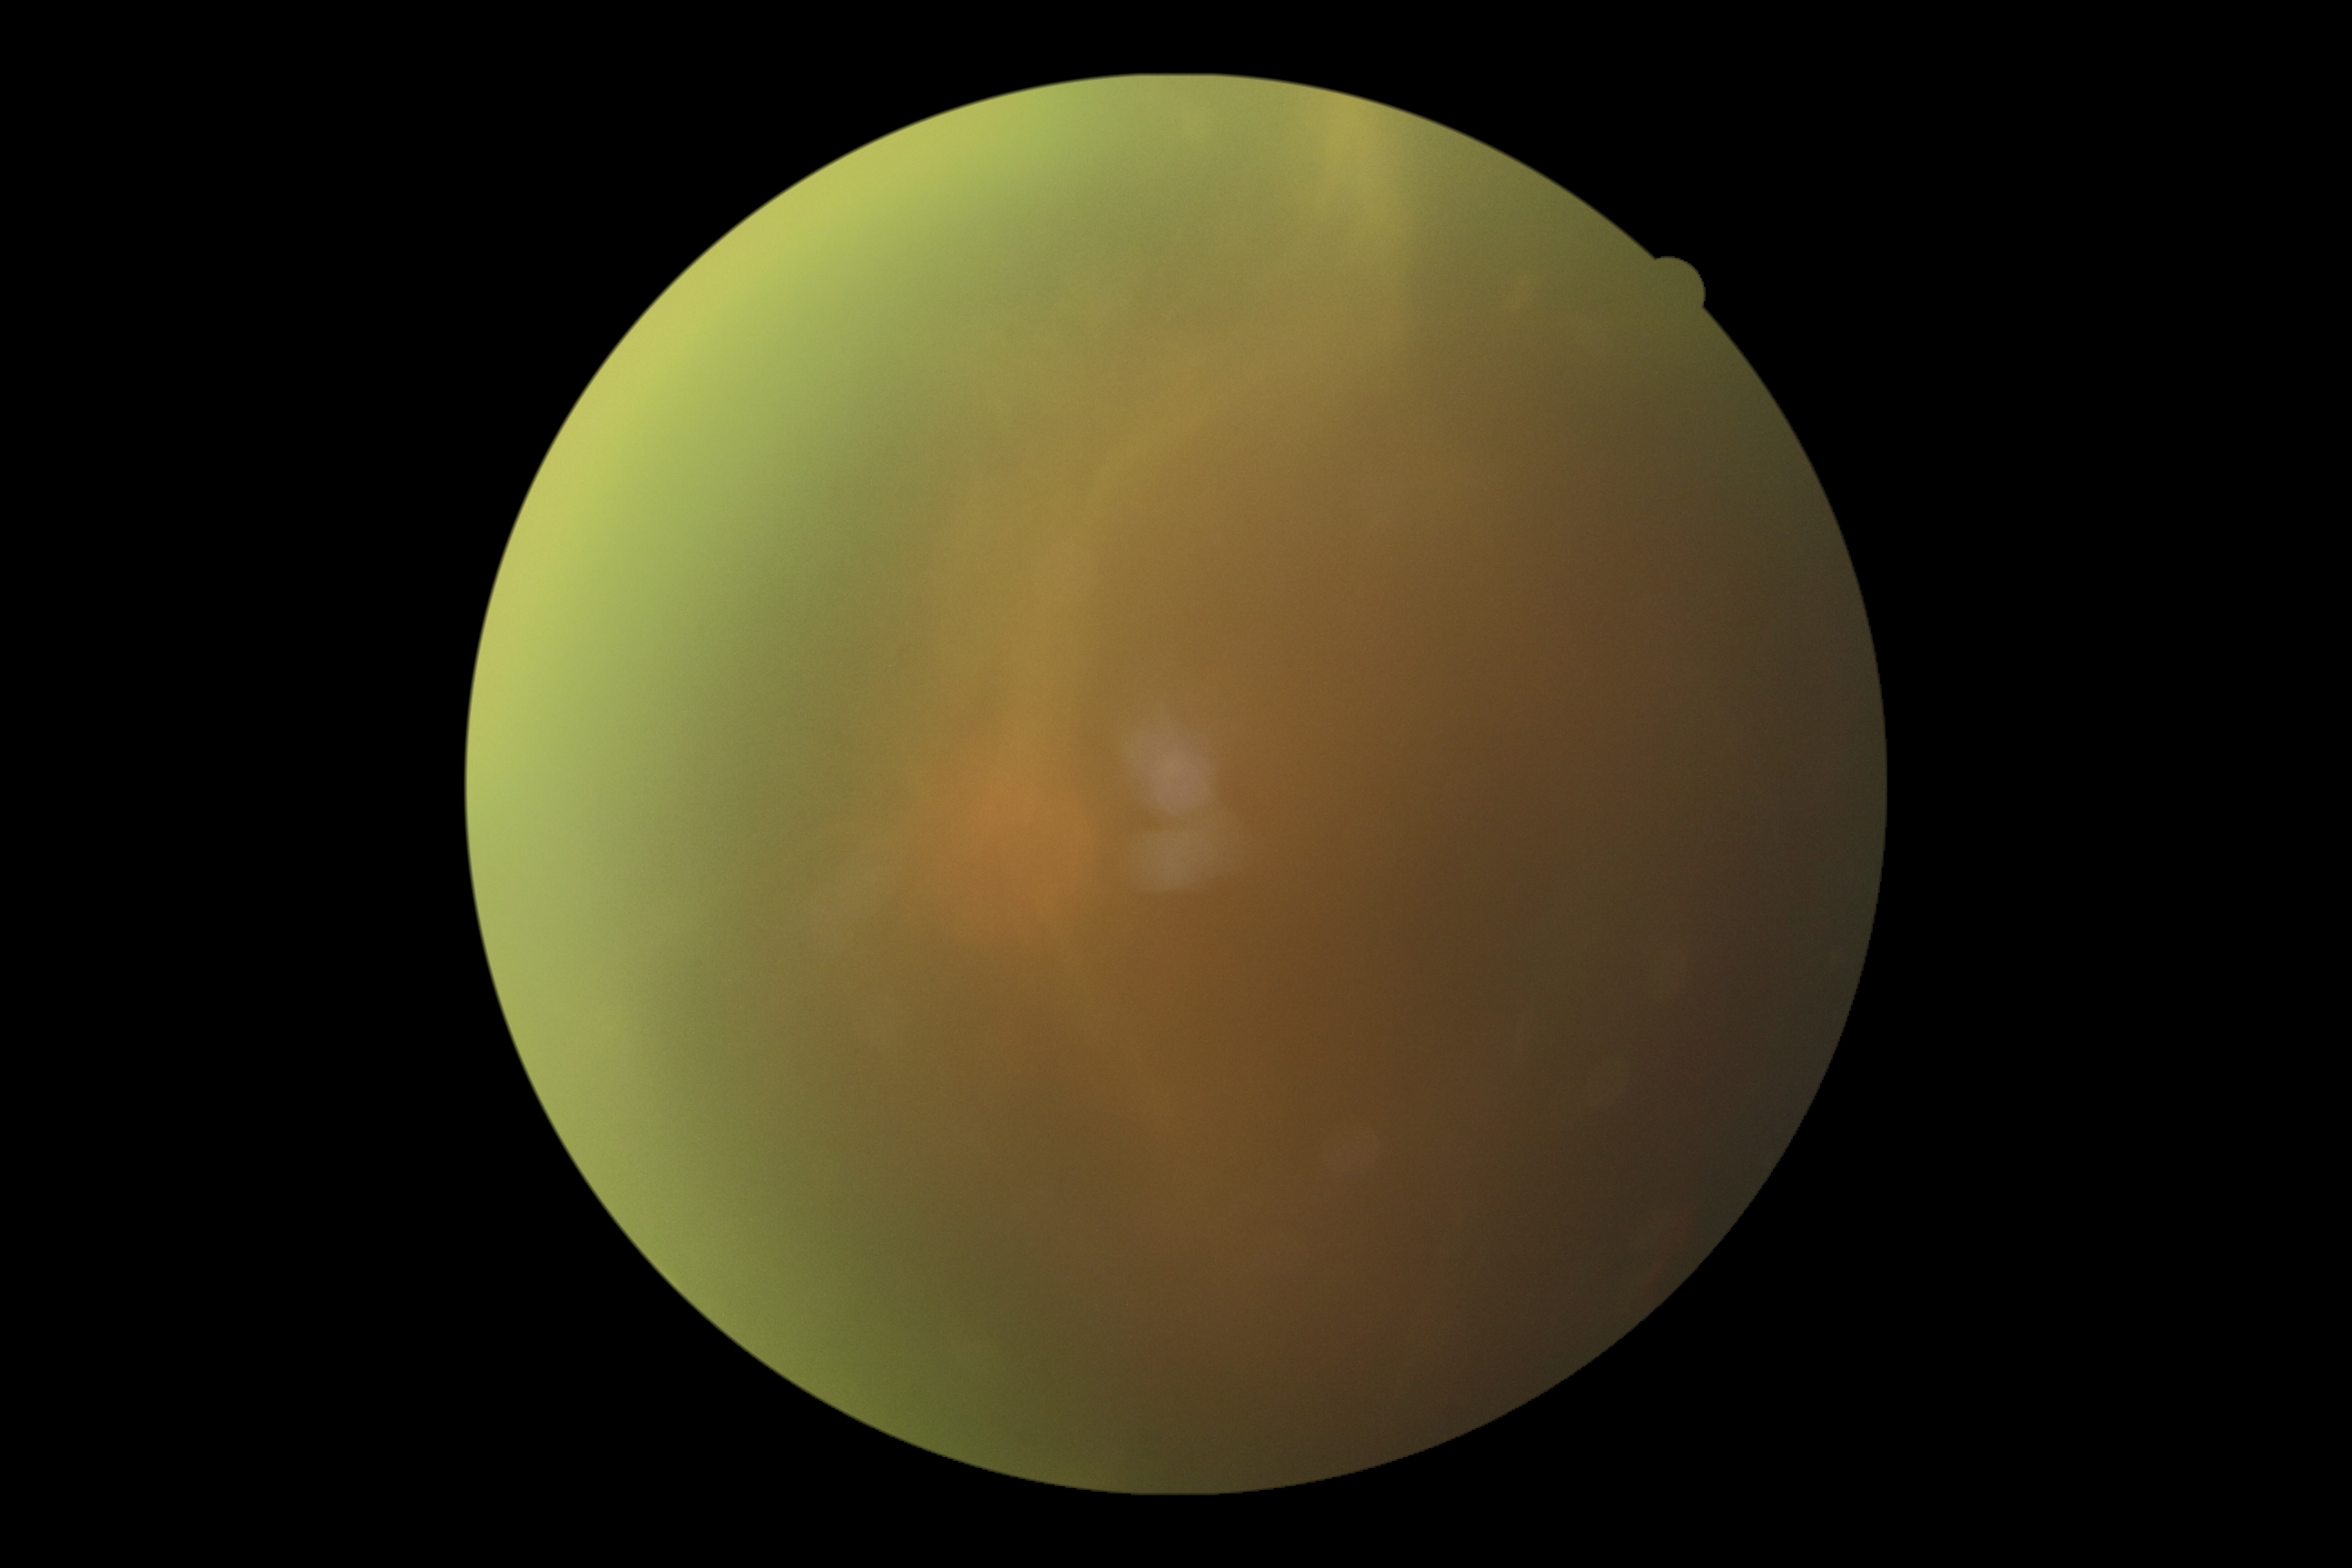
DR stage: grade 4 — neovascularization and/or vitreous/pre-retinal hemorrhage.